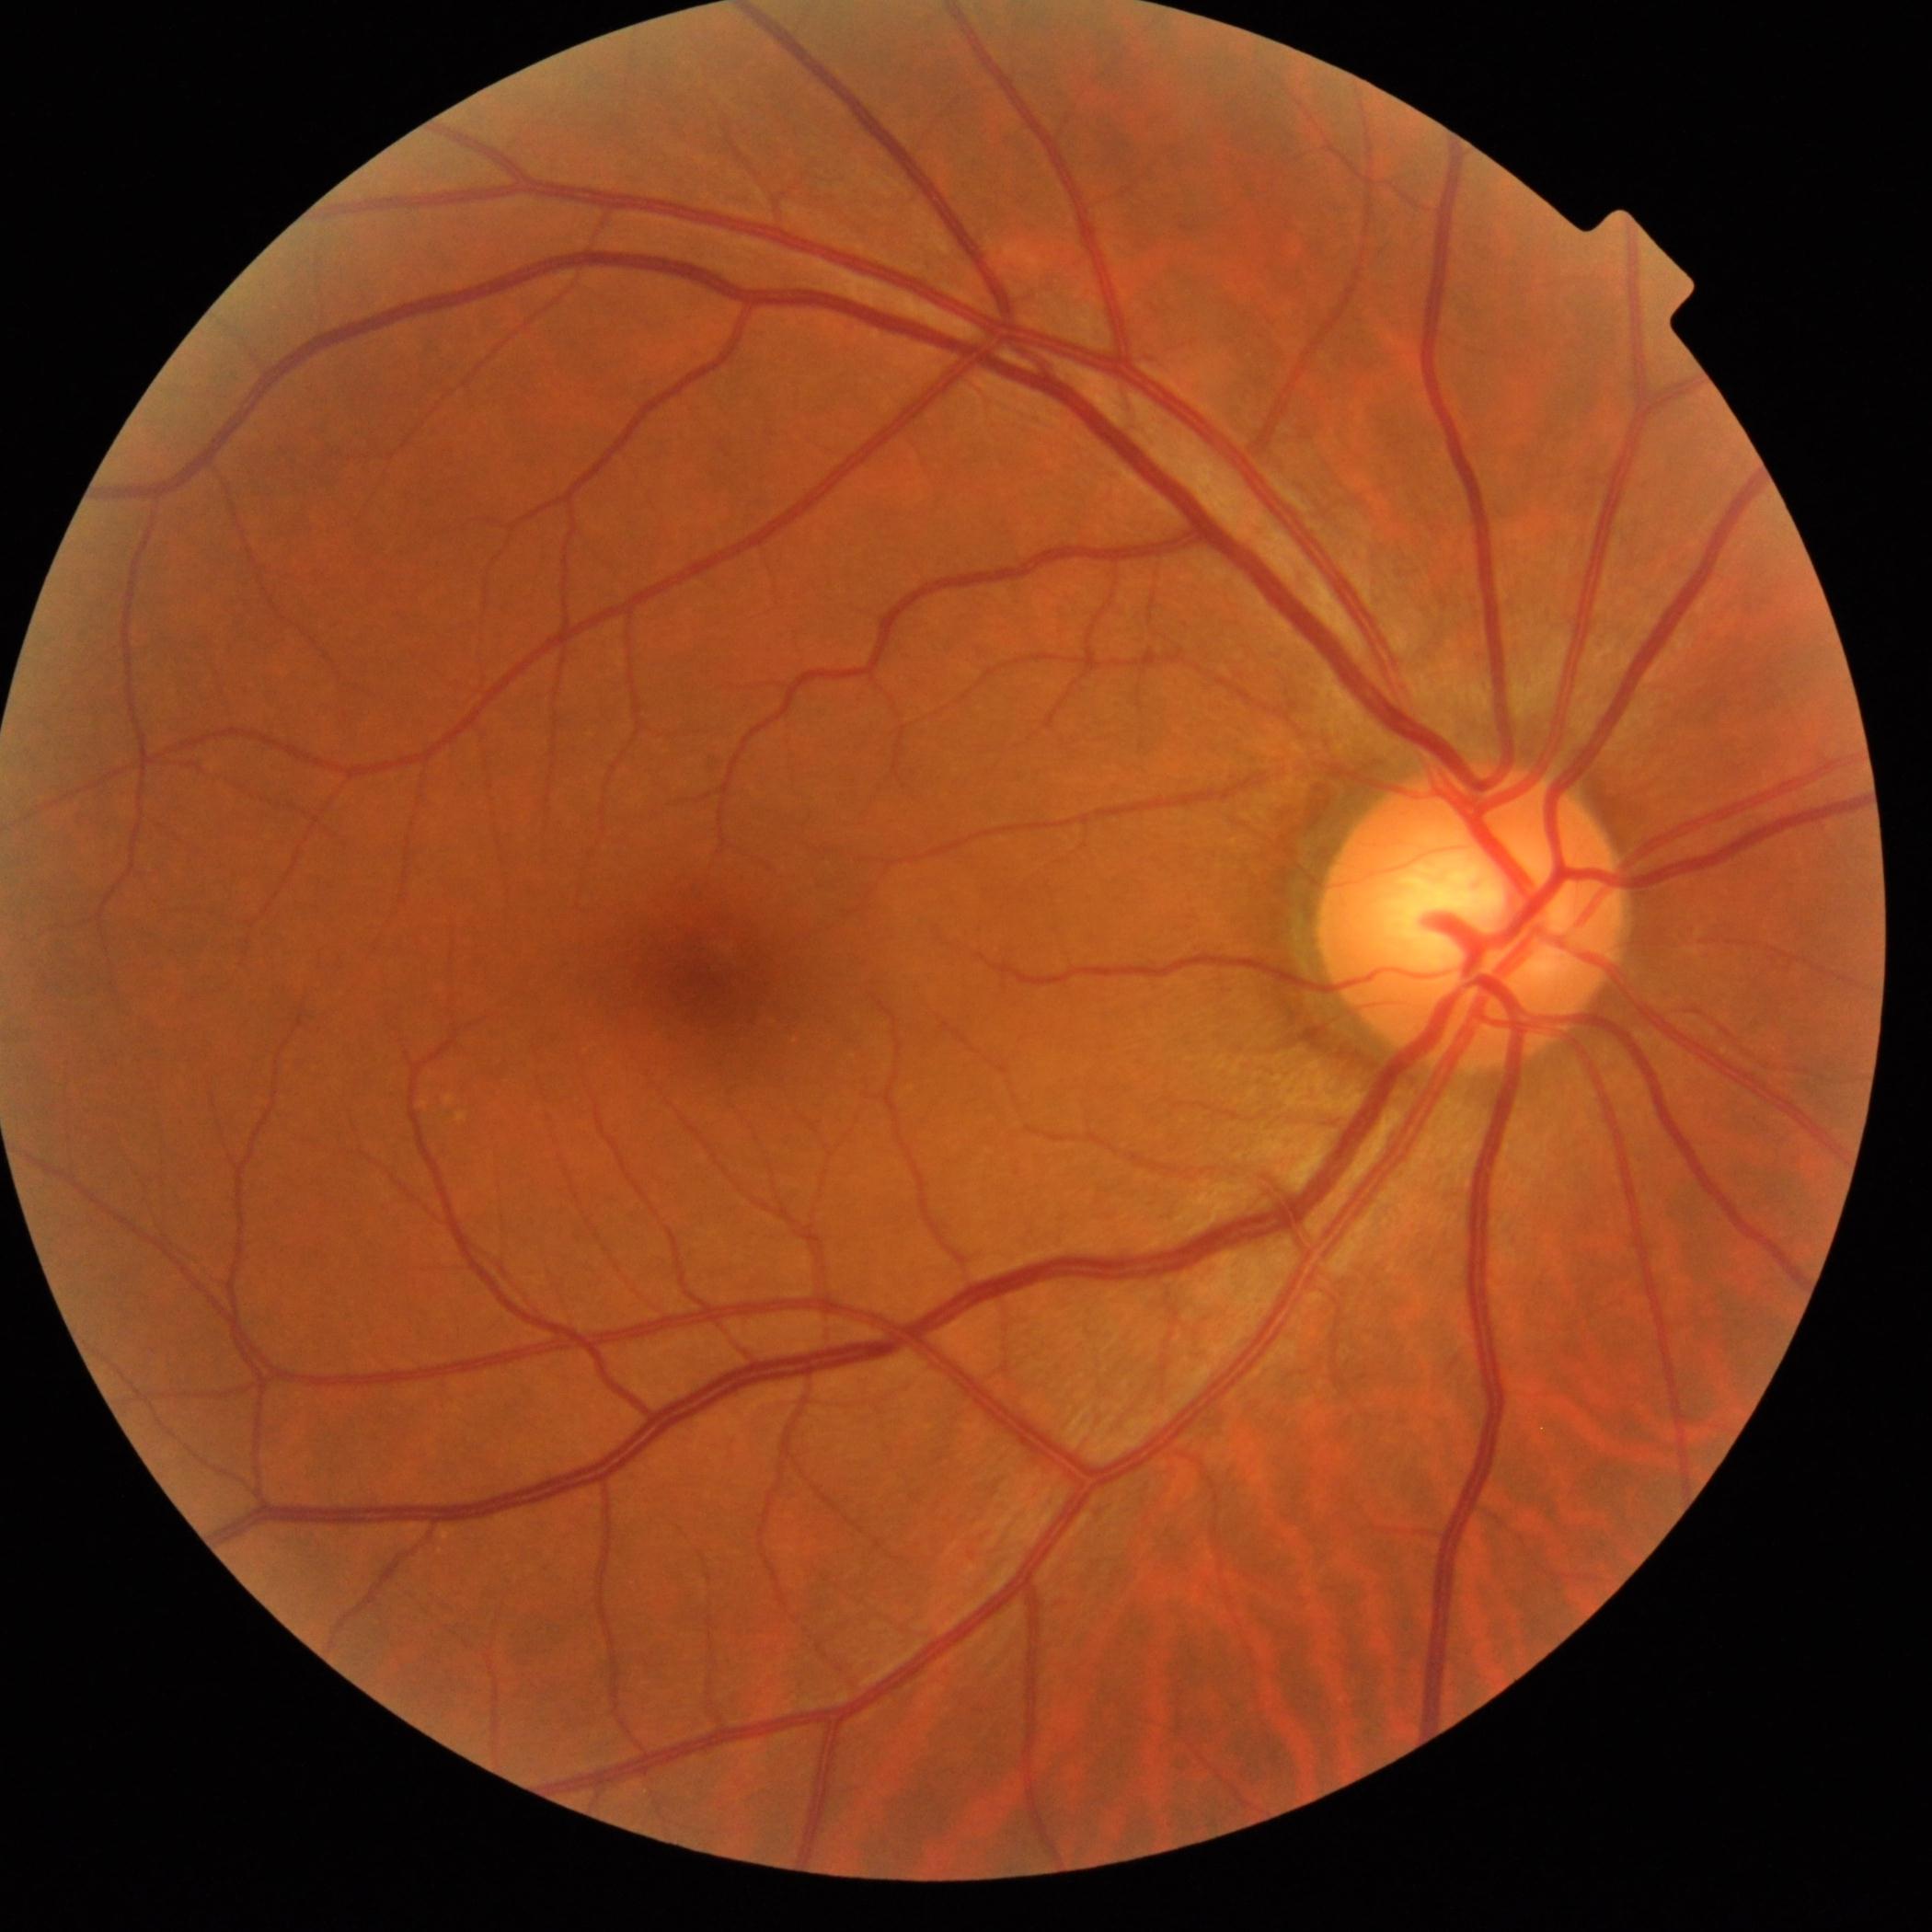
  dr_grade: grade 0 (no apparent retinopathy) — no visible signs of diabetic retinopathy